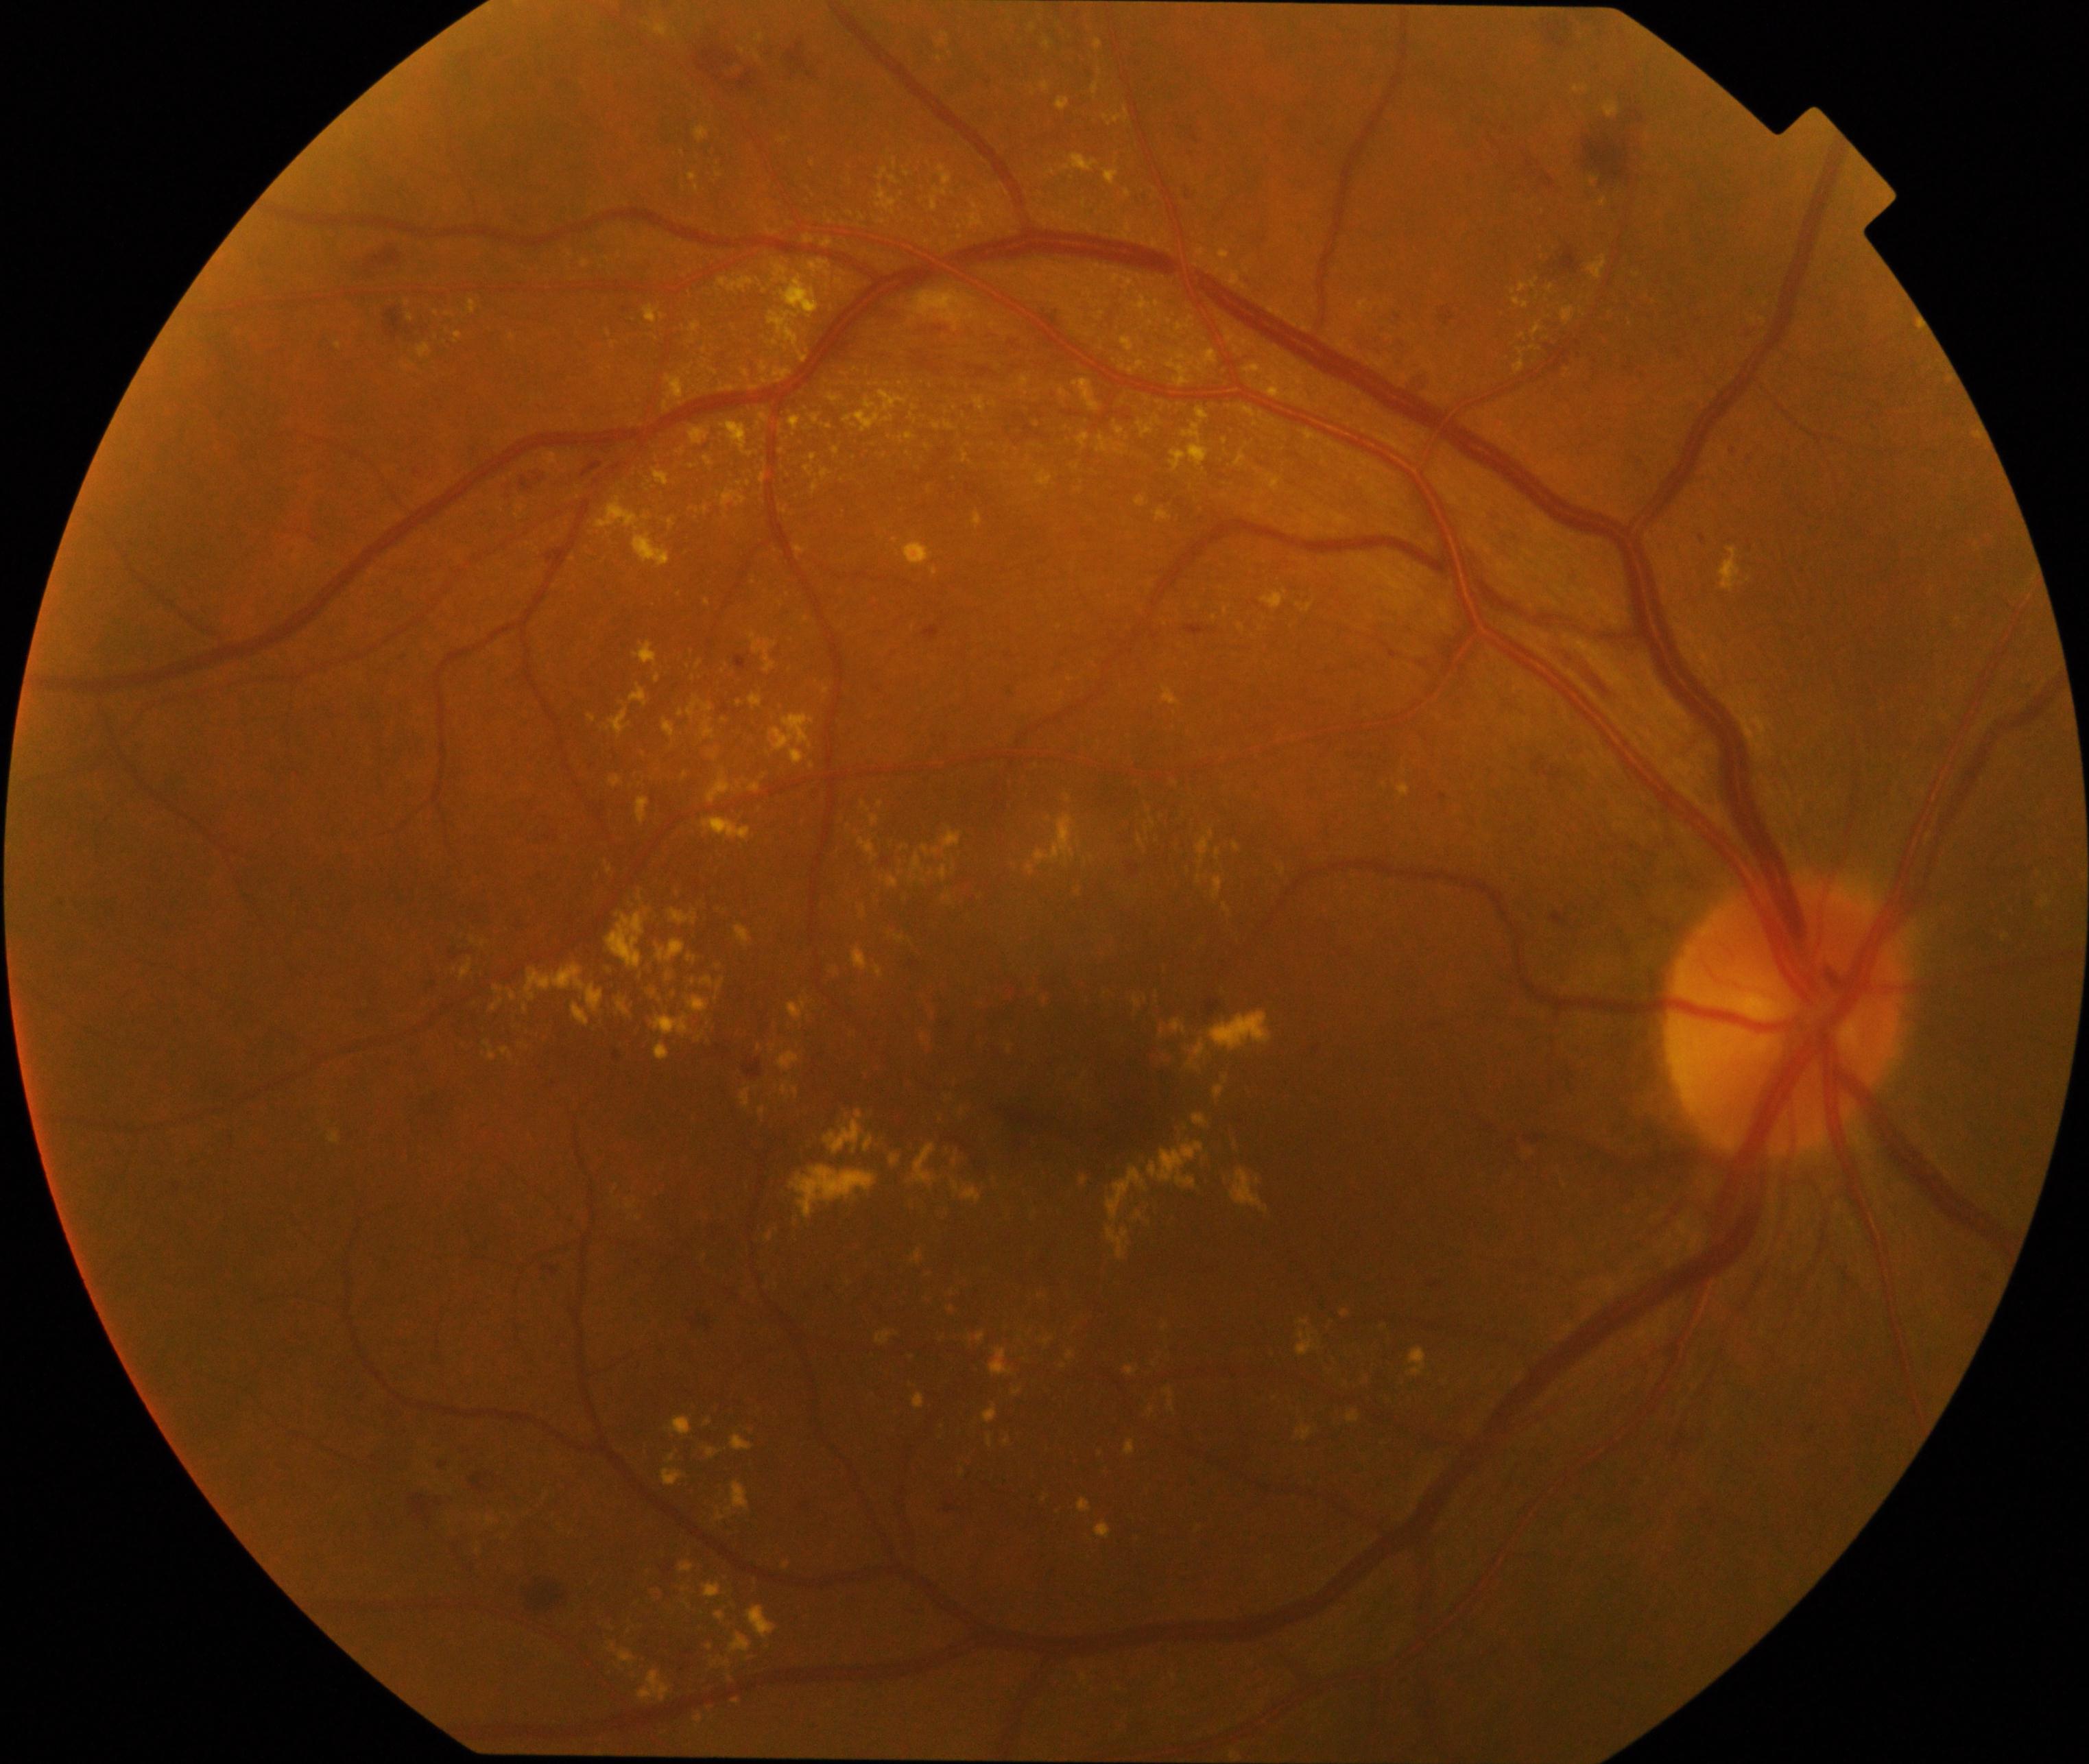 This fundus photograph shows moderate non-proliferative diabetic retinopathy.